Posterior pole photograph. Image size 848x848. 45-degree field of view:
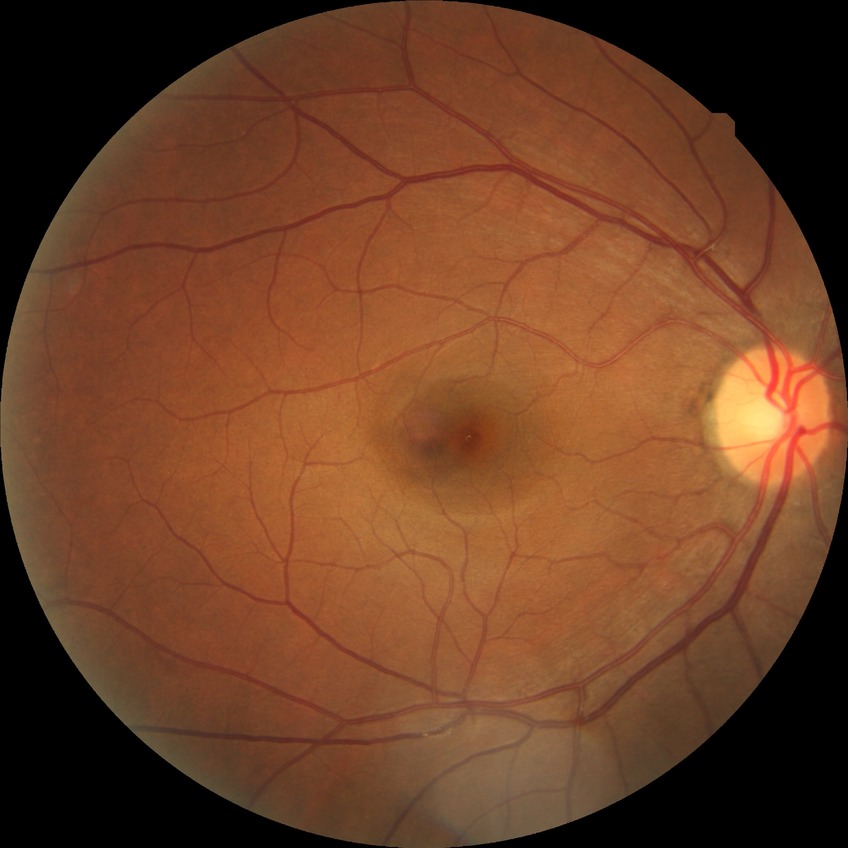

diabetic retinopathy (DR)@NDR (no diabetic retinopathy).